848 by 848 pixels · 45° field of view.
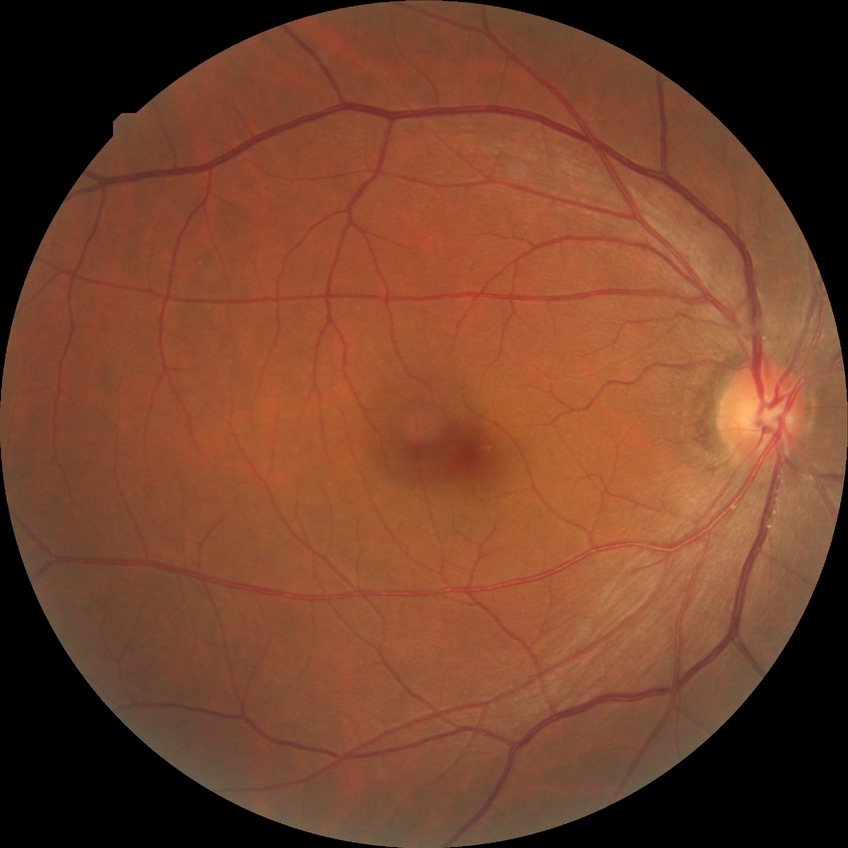
Diabetic retinopathy (DR) is NDR (no diabetic retinopathy).